Optic disc-centered crop from a color fundus photograph: 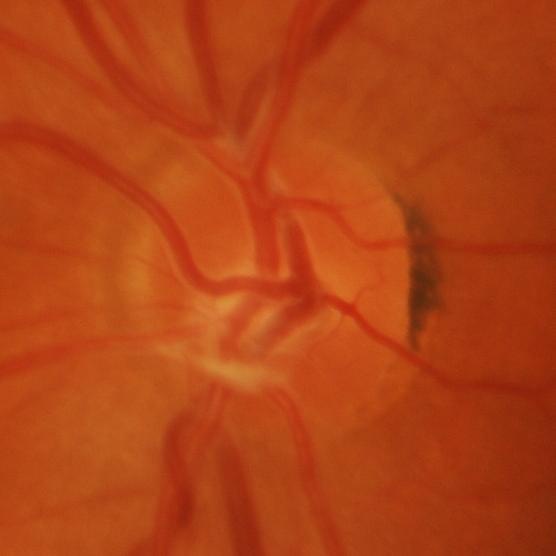 Diagnosis = glaucoma.